Color fundus photograph: 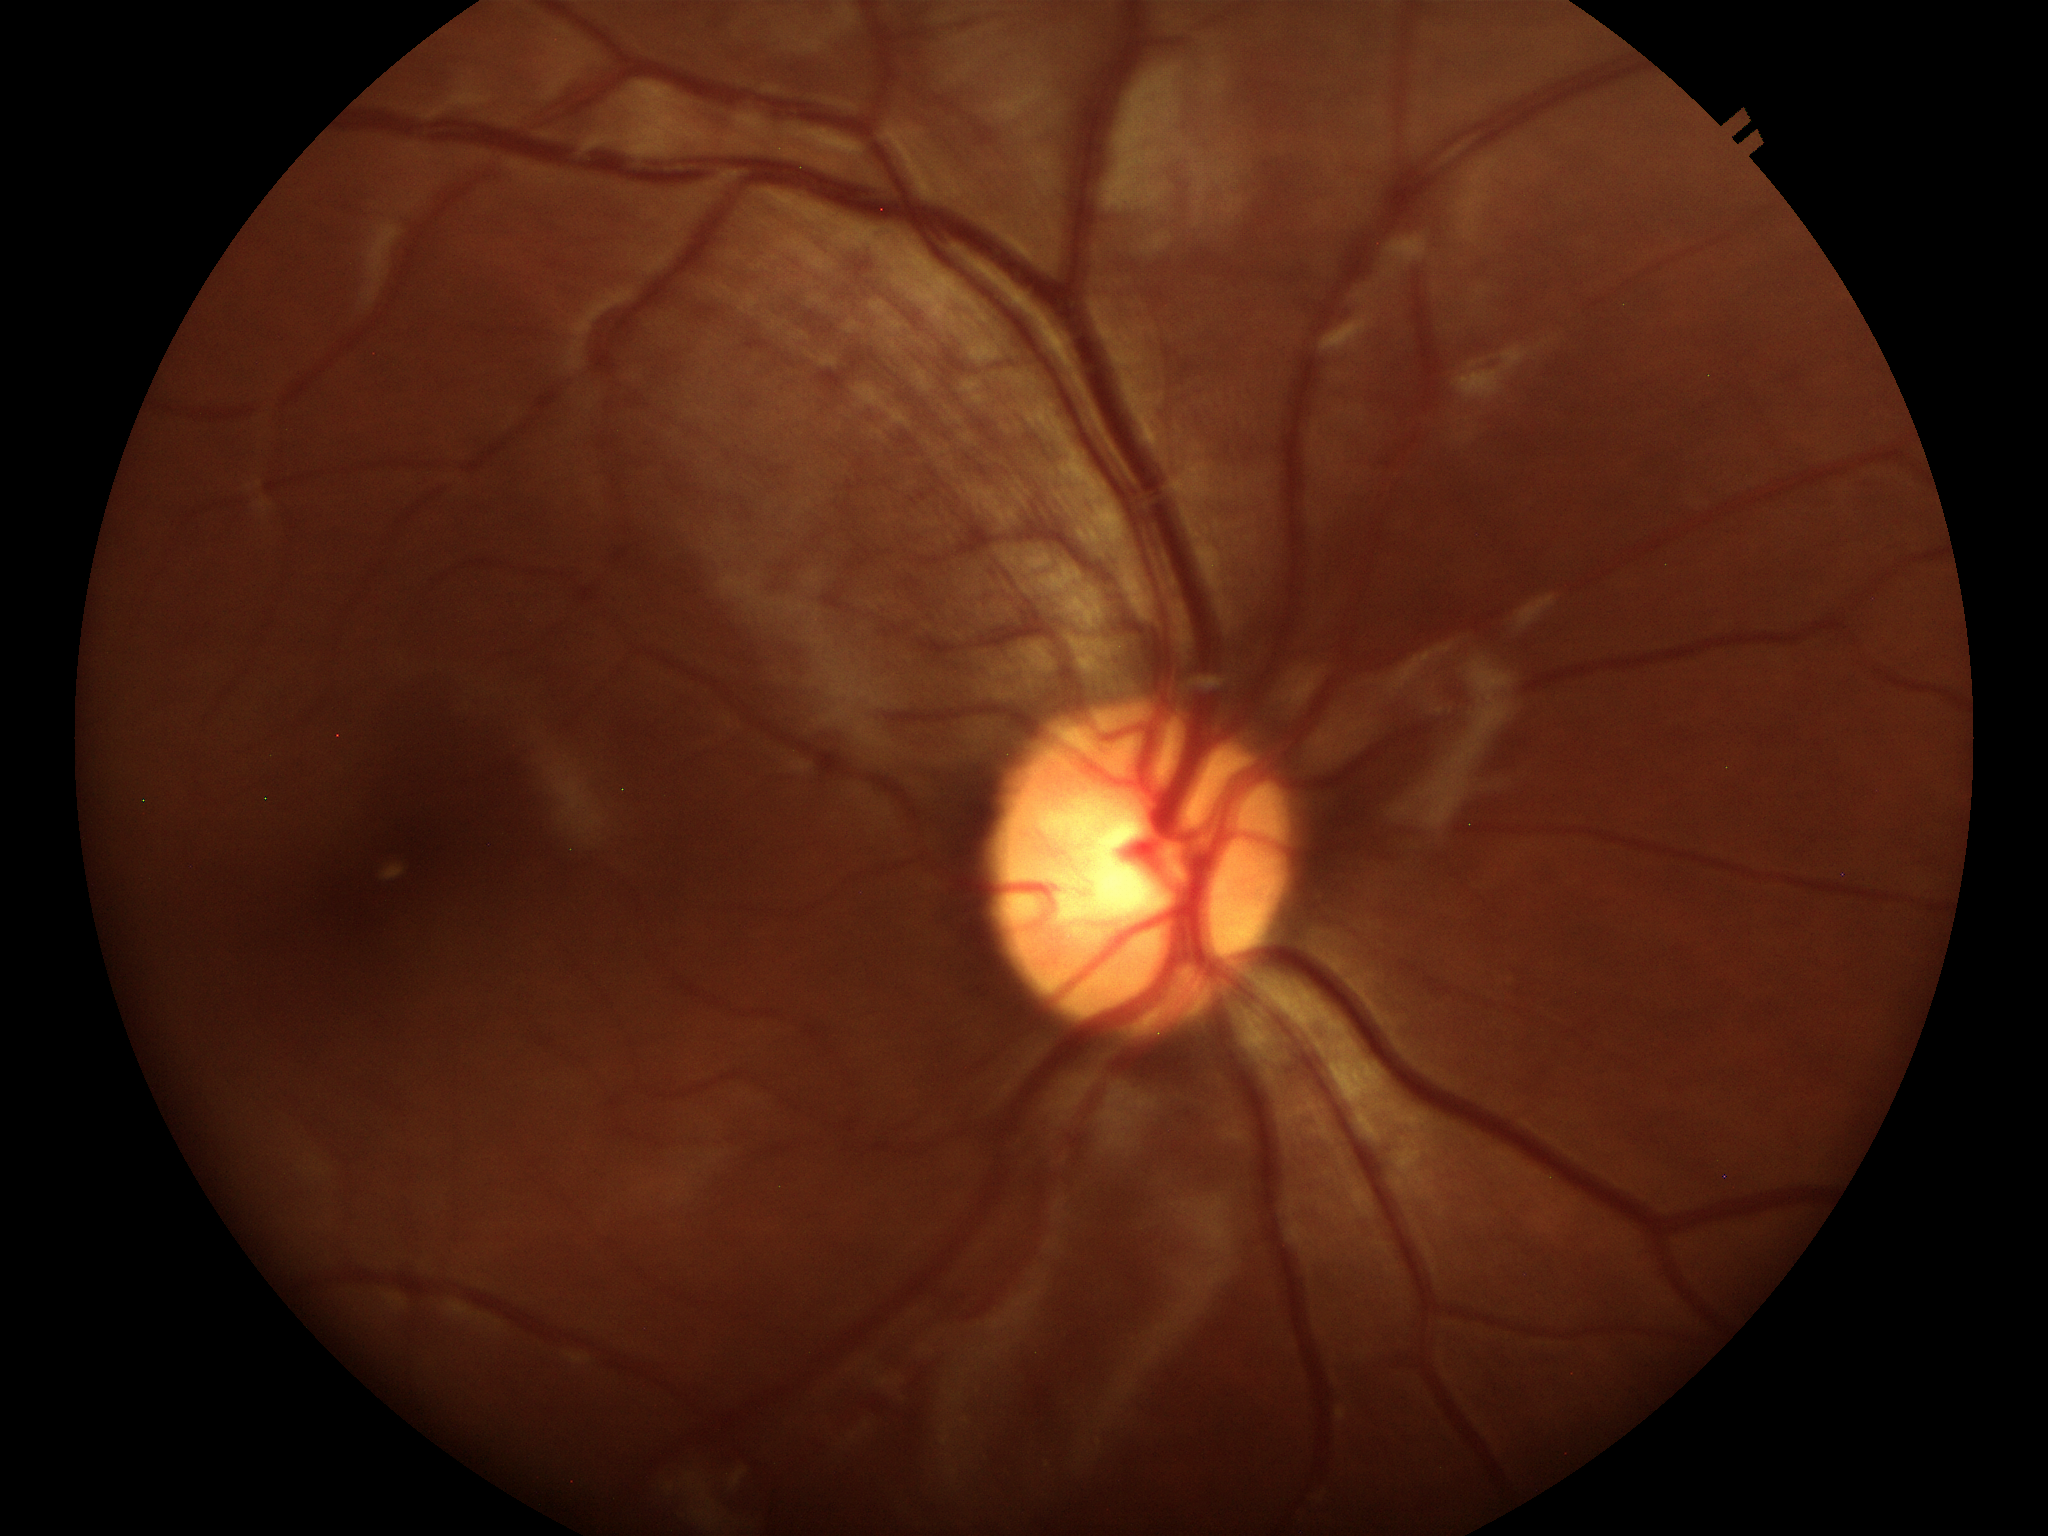

Vertical cup-disc ratio is 0.52.
Glaucoma screening impression: negative.